848 x 848 pixels · no pharmacologic dilation — 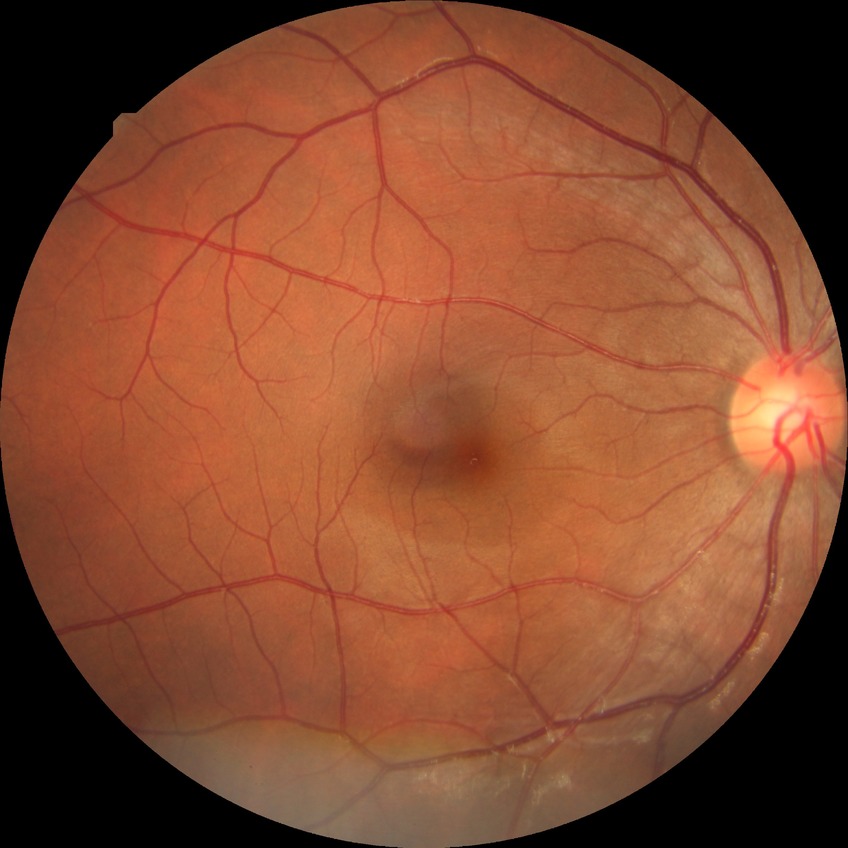 Modified Davis grading is no diabetic retinopathy.